2212 x 1659 pixels · 45-degree field of view
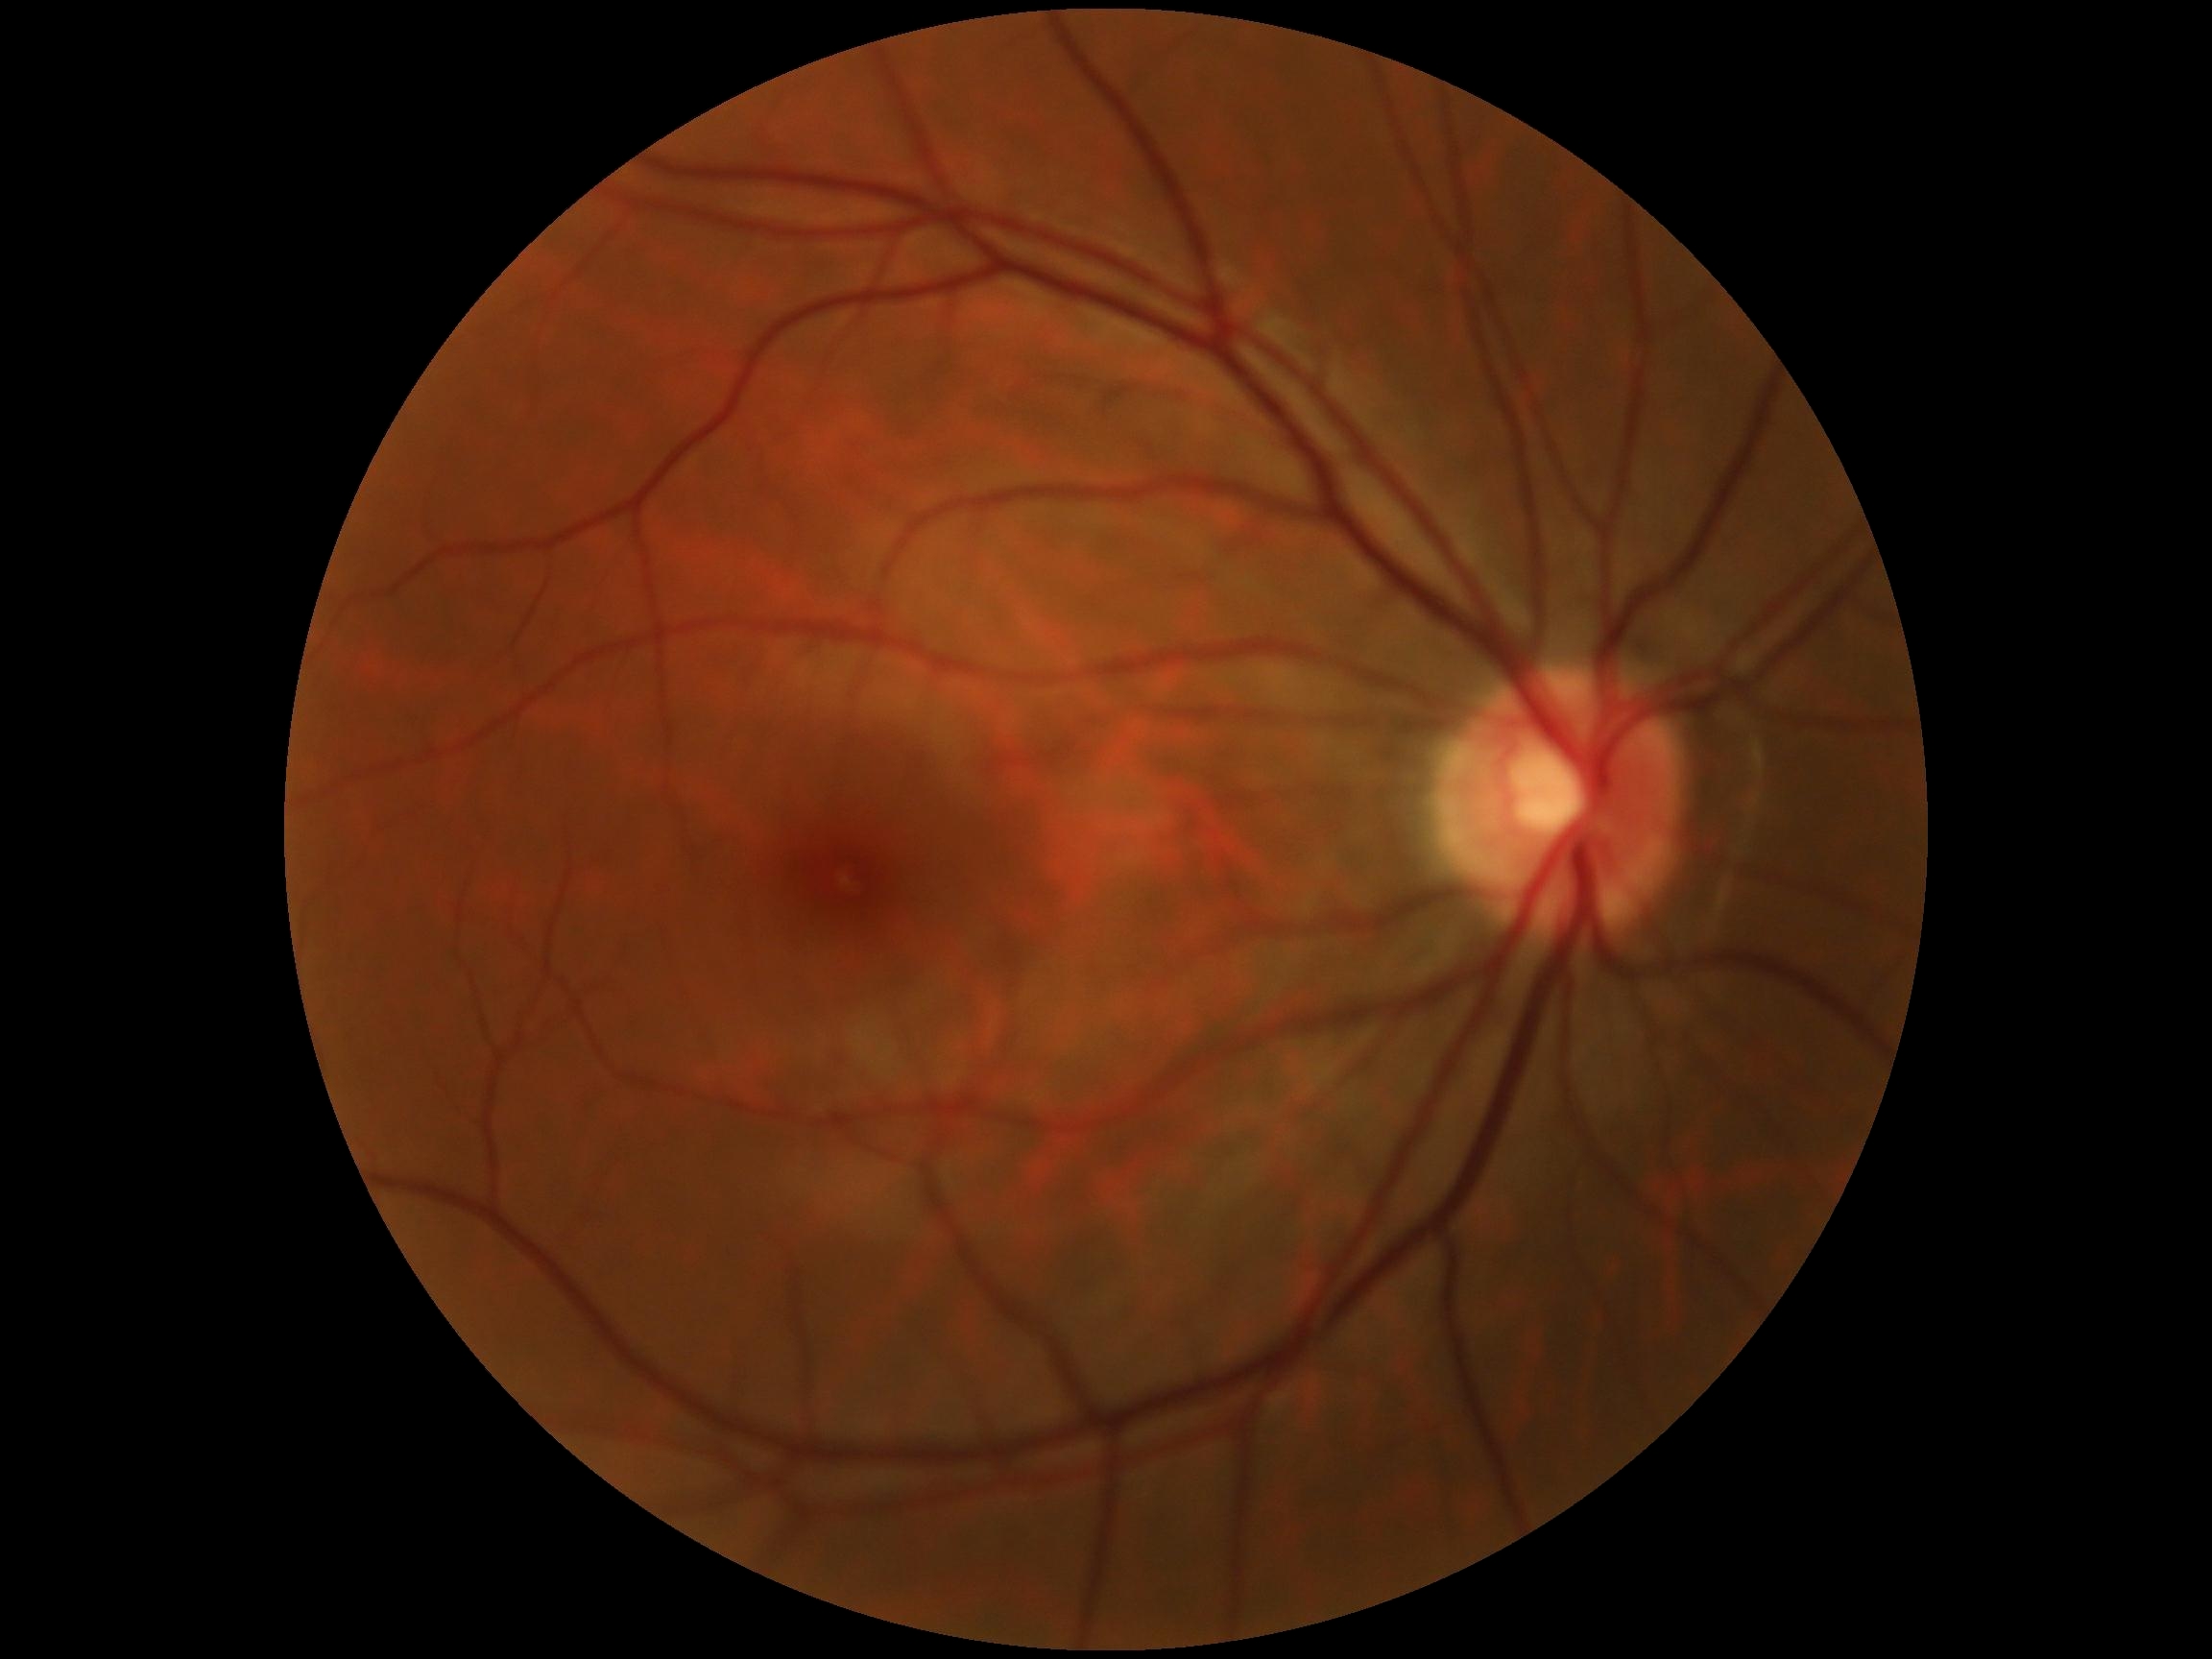 Retinopathy grade: 0/4 — no visible signs of diabetic retinopathy. No DR findings.